Retinal fundus photograph; 45° field of view: 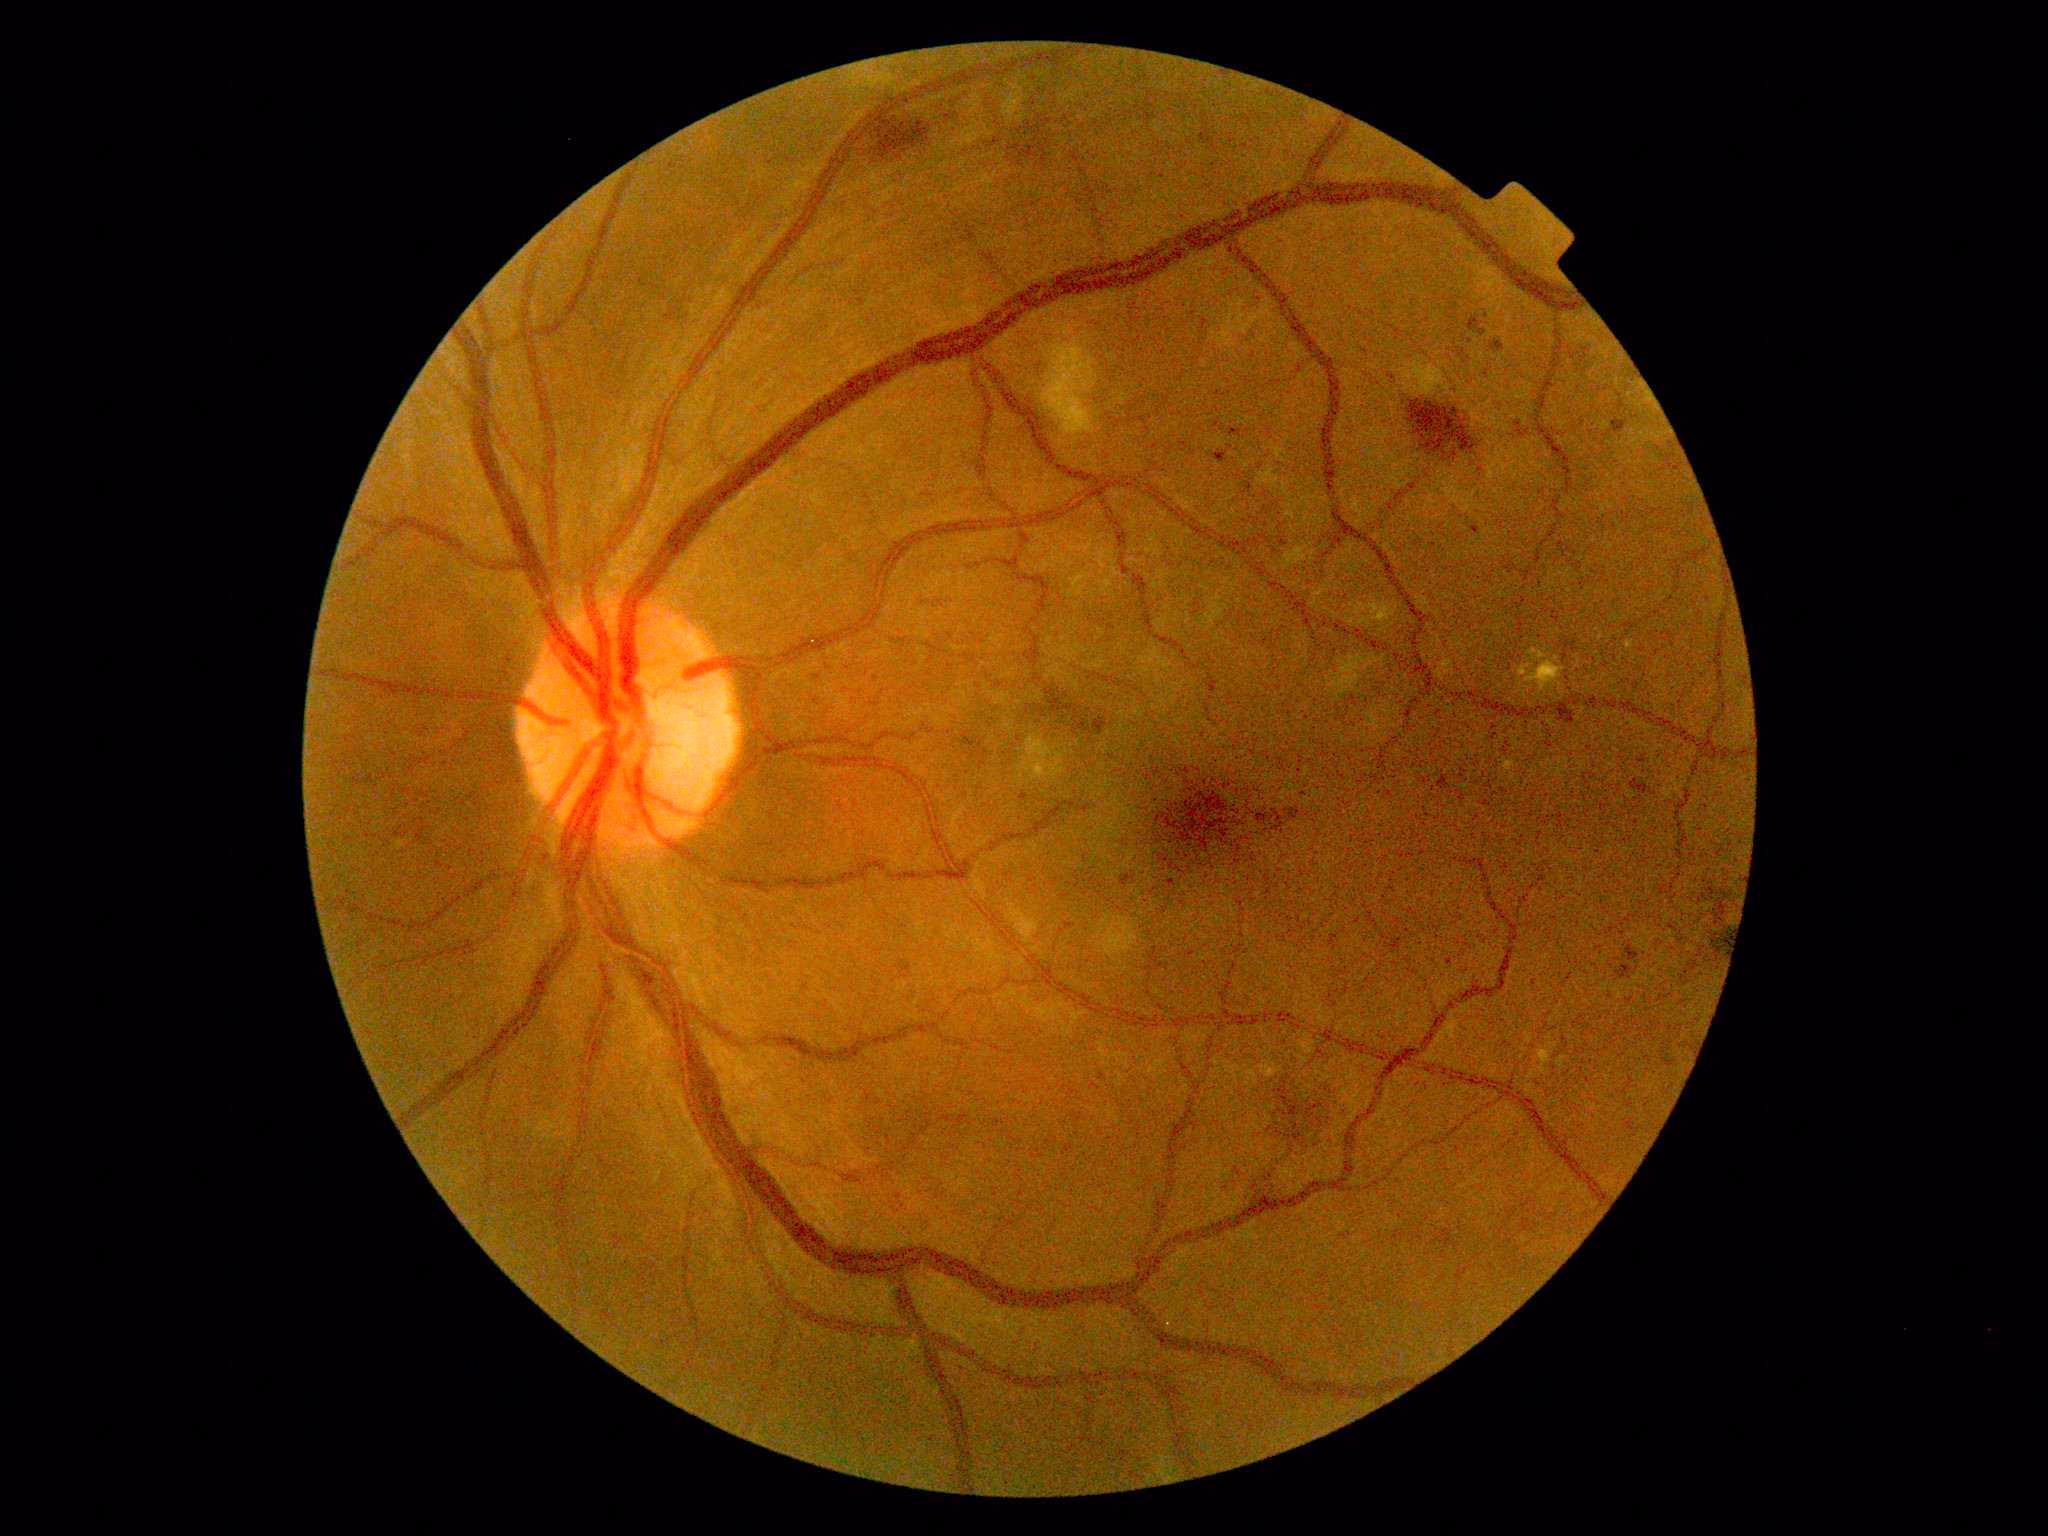

diabetic retinopathy (DR) = 2/4 — more than just microaneurysms but less than severe NPDR.